Diabetic retinopathy graded by the modified Davis classification; 45 degree fundus photograph; 848 by 848 pixels; camera: NIDEK AFC-230; fundus photo:
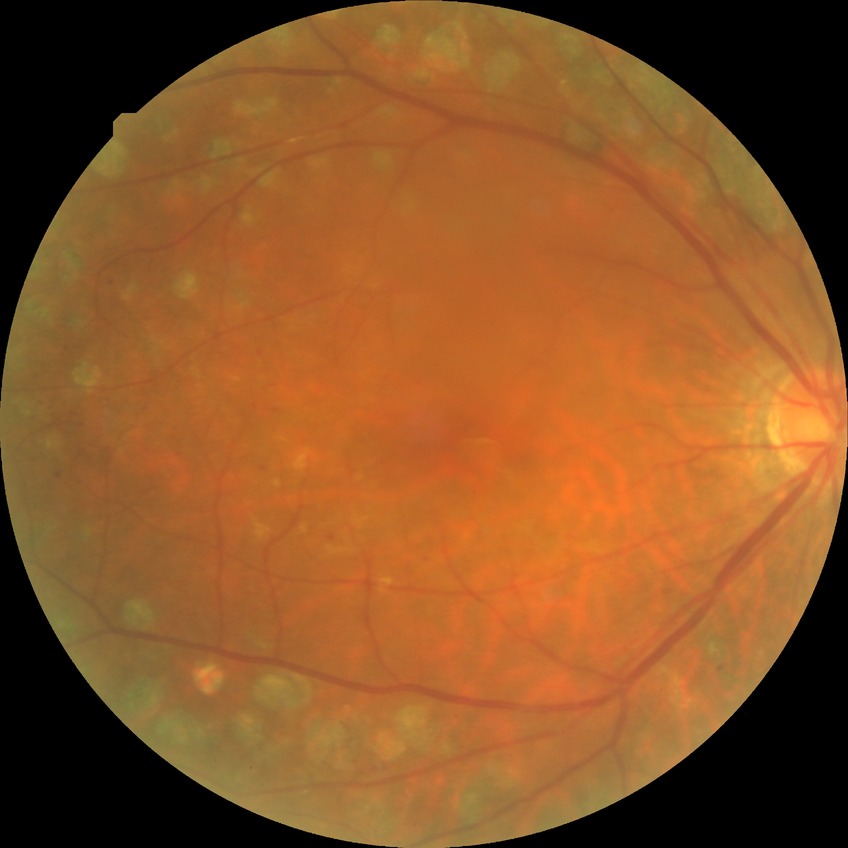
Diabetic retinopathy stage is proliferative diabetic retinopathy.